Davis DR grading — 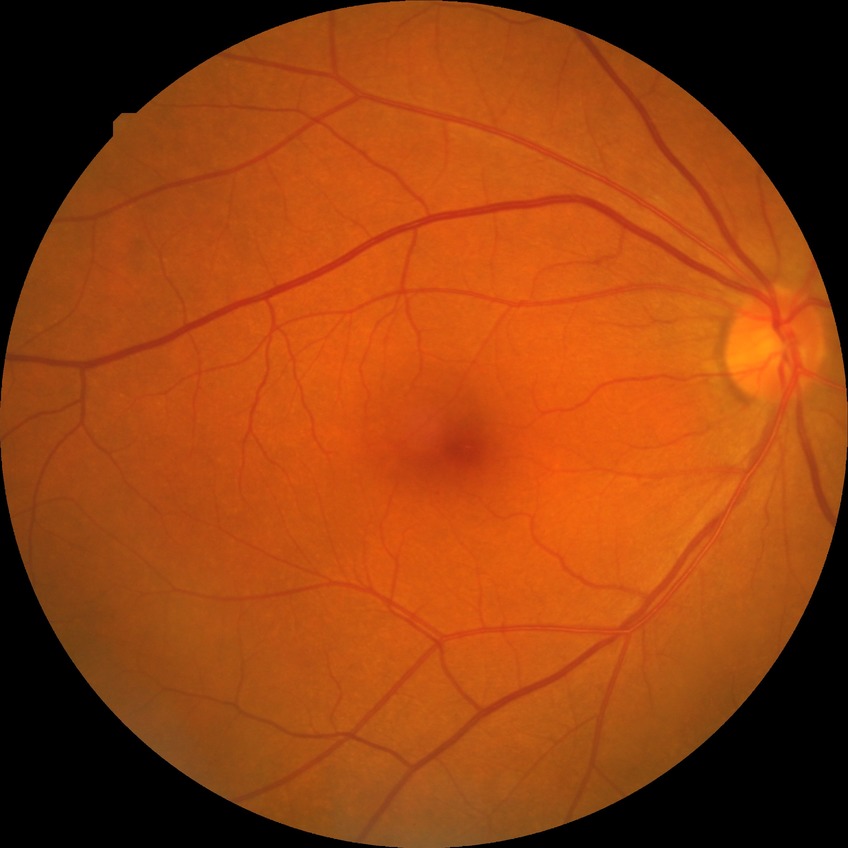 Diabetic retinopathy (DR) is SDR (simple diabetic retinopathy).